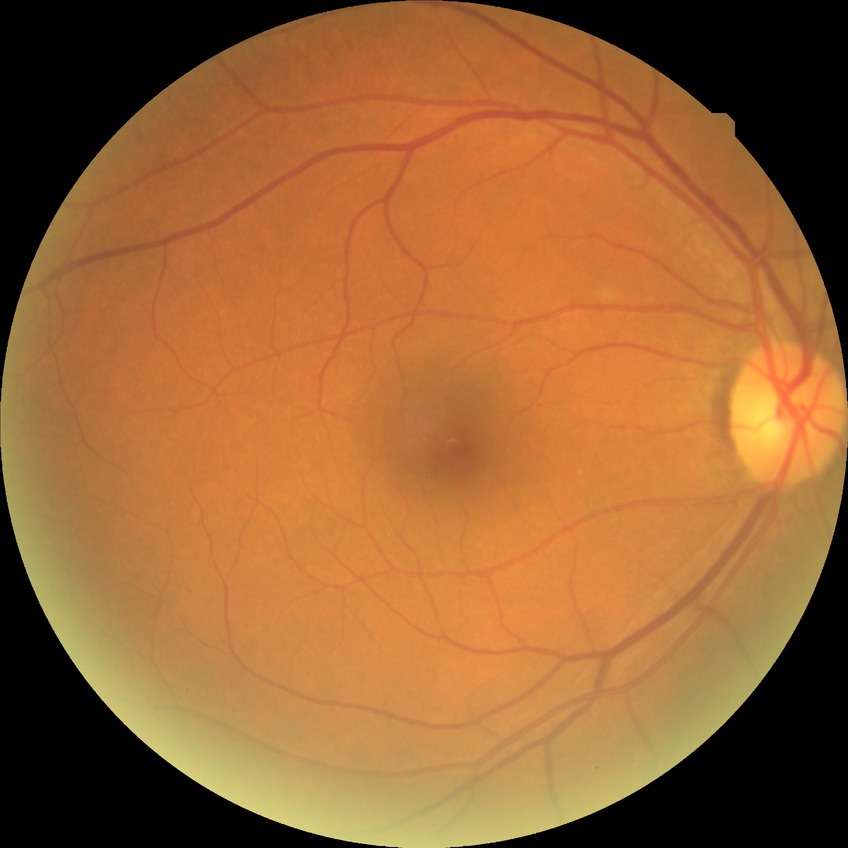
Modified Davis classification is no diabetic retinopathy.